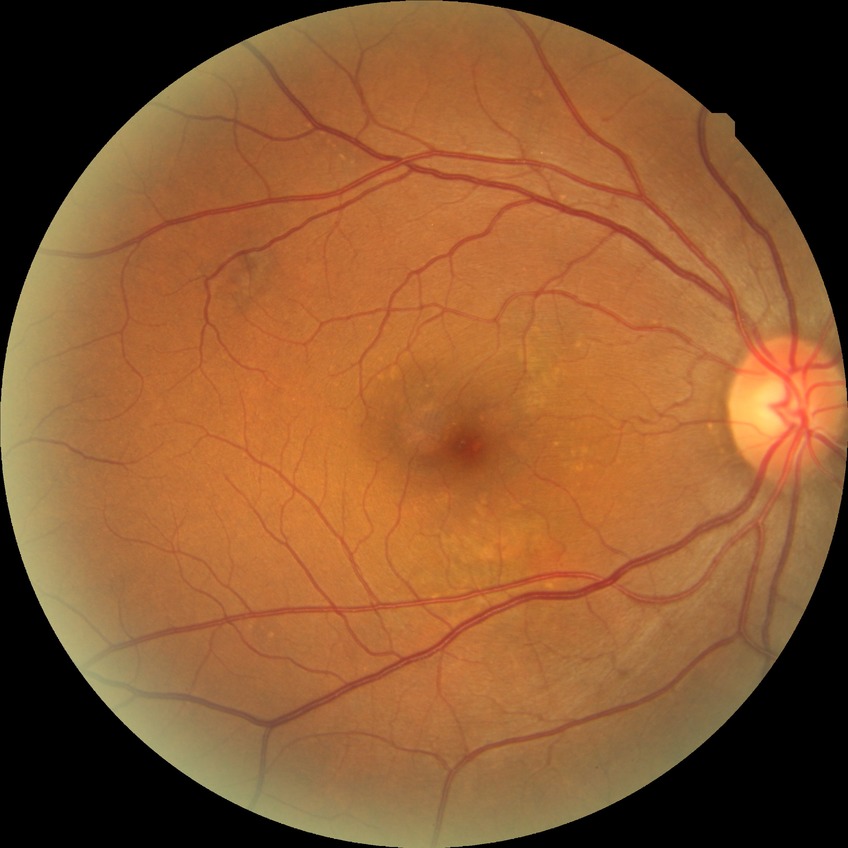 Davis stage: NDR. No signs of diabetic retinopathy.